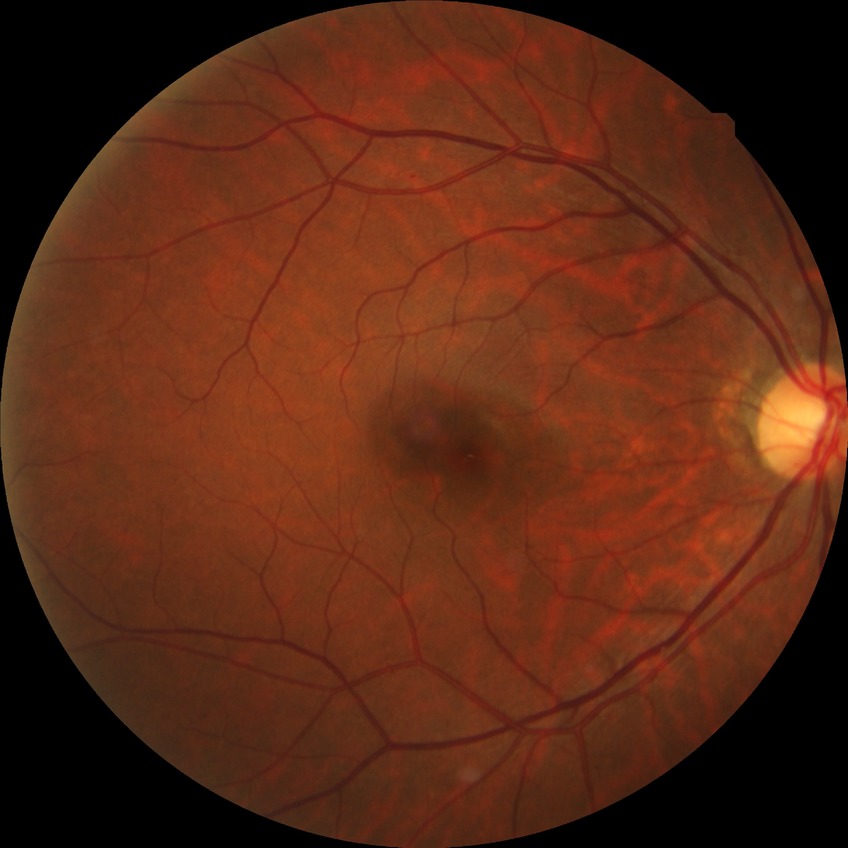 Diabetic retinopathy (DR): no diabetic retinopathy (NDR).